Mydriatic acquisition; optic nerve head photograph.
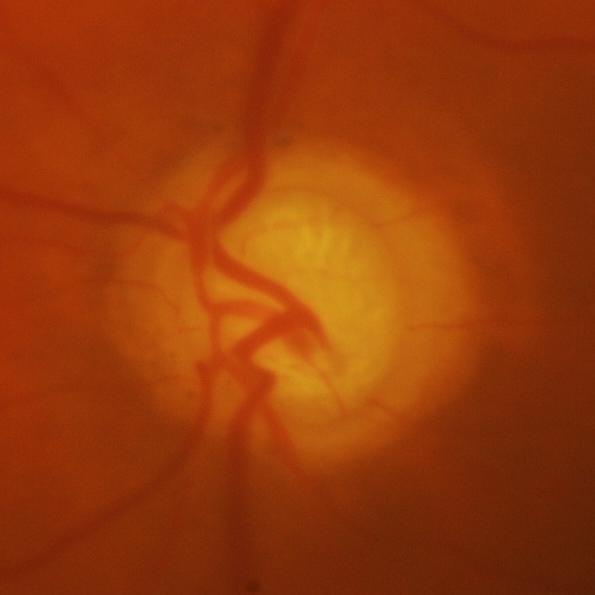 Q: What is the glaucoma diagnosis?
A: Yes — glaucoma.